45° FOV
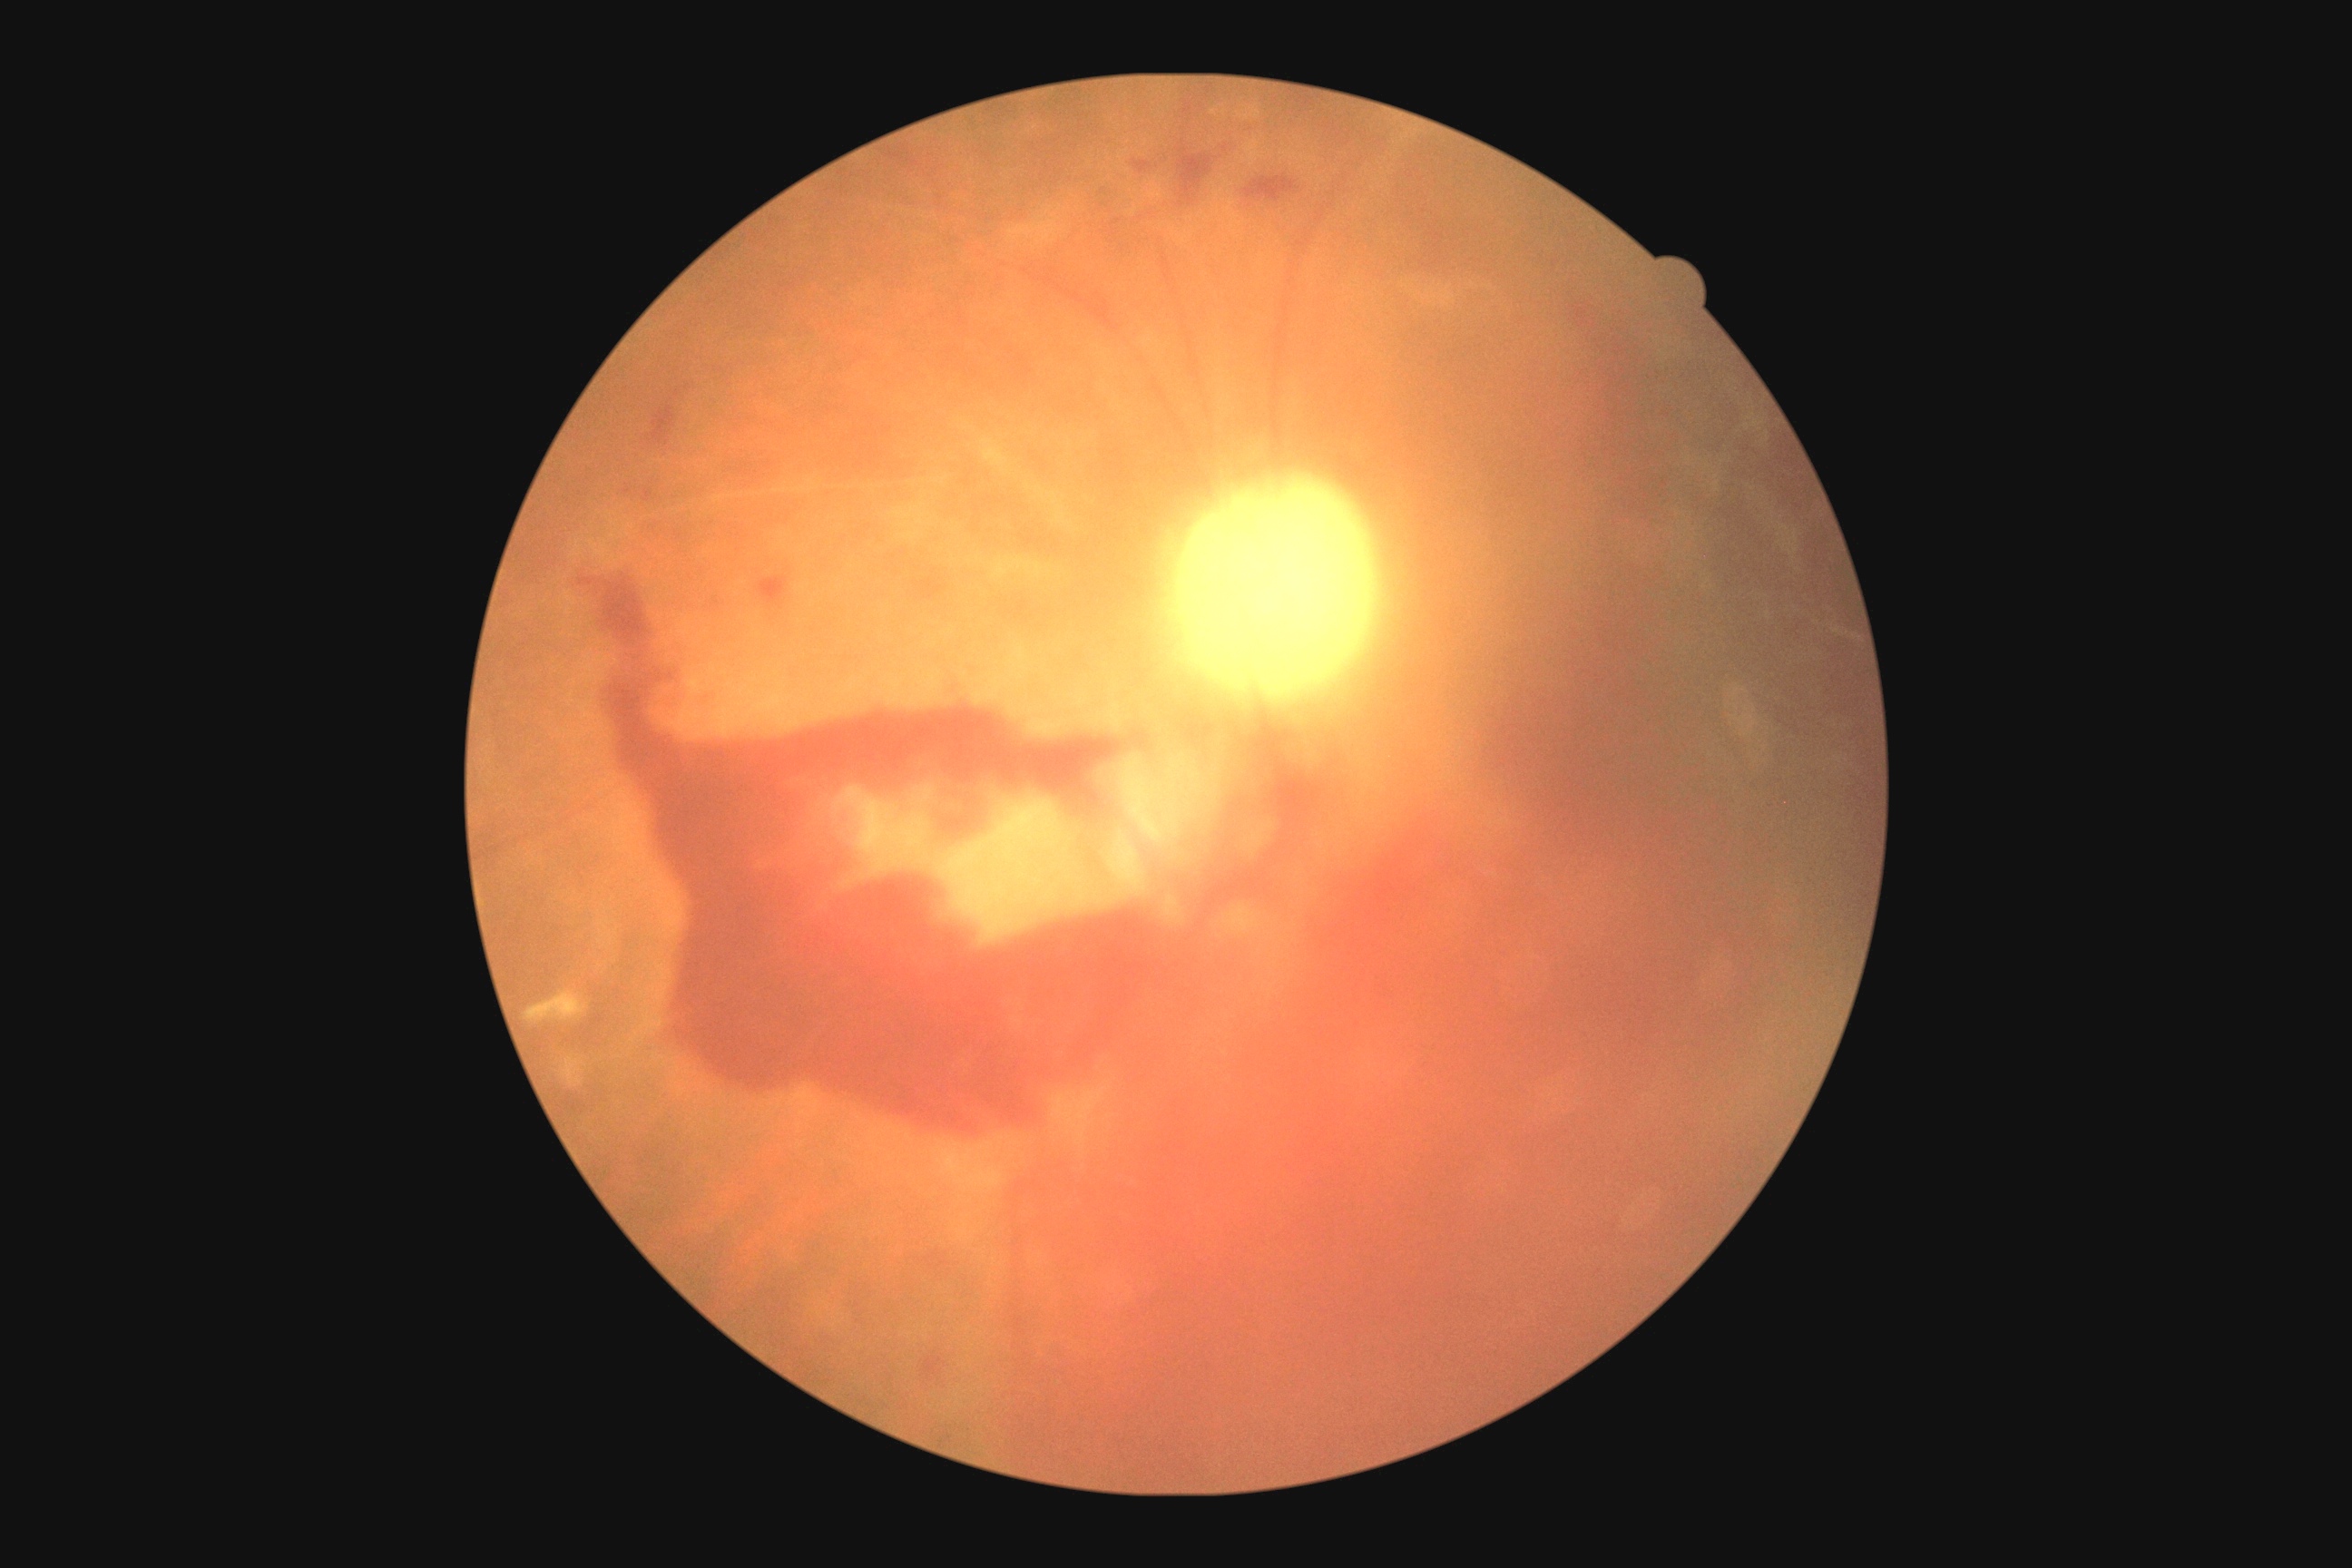

{"dr_grade": "4/4"}